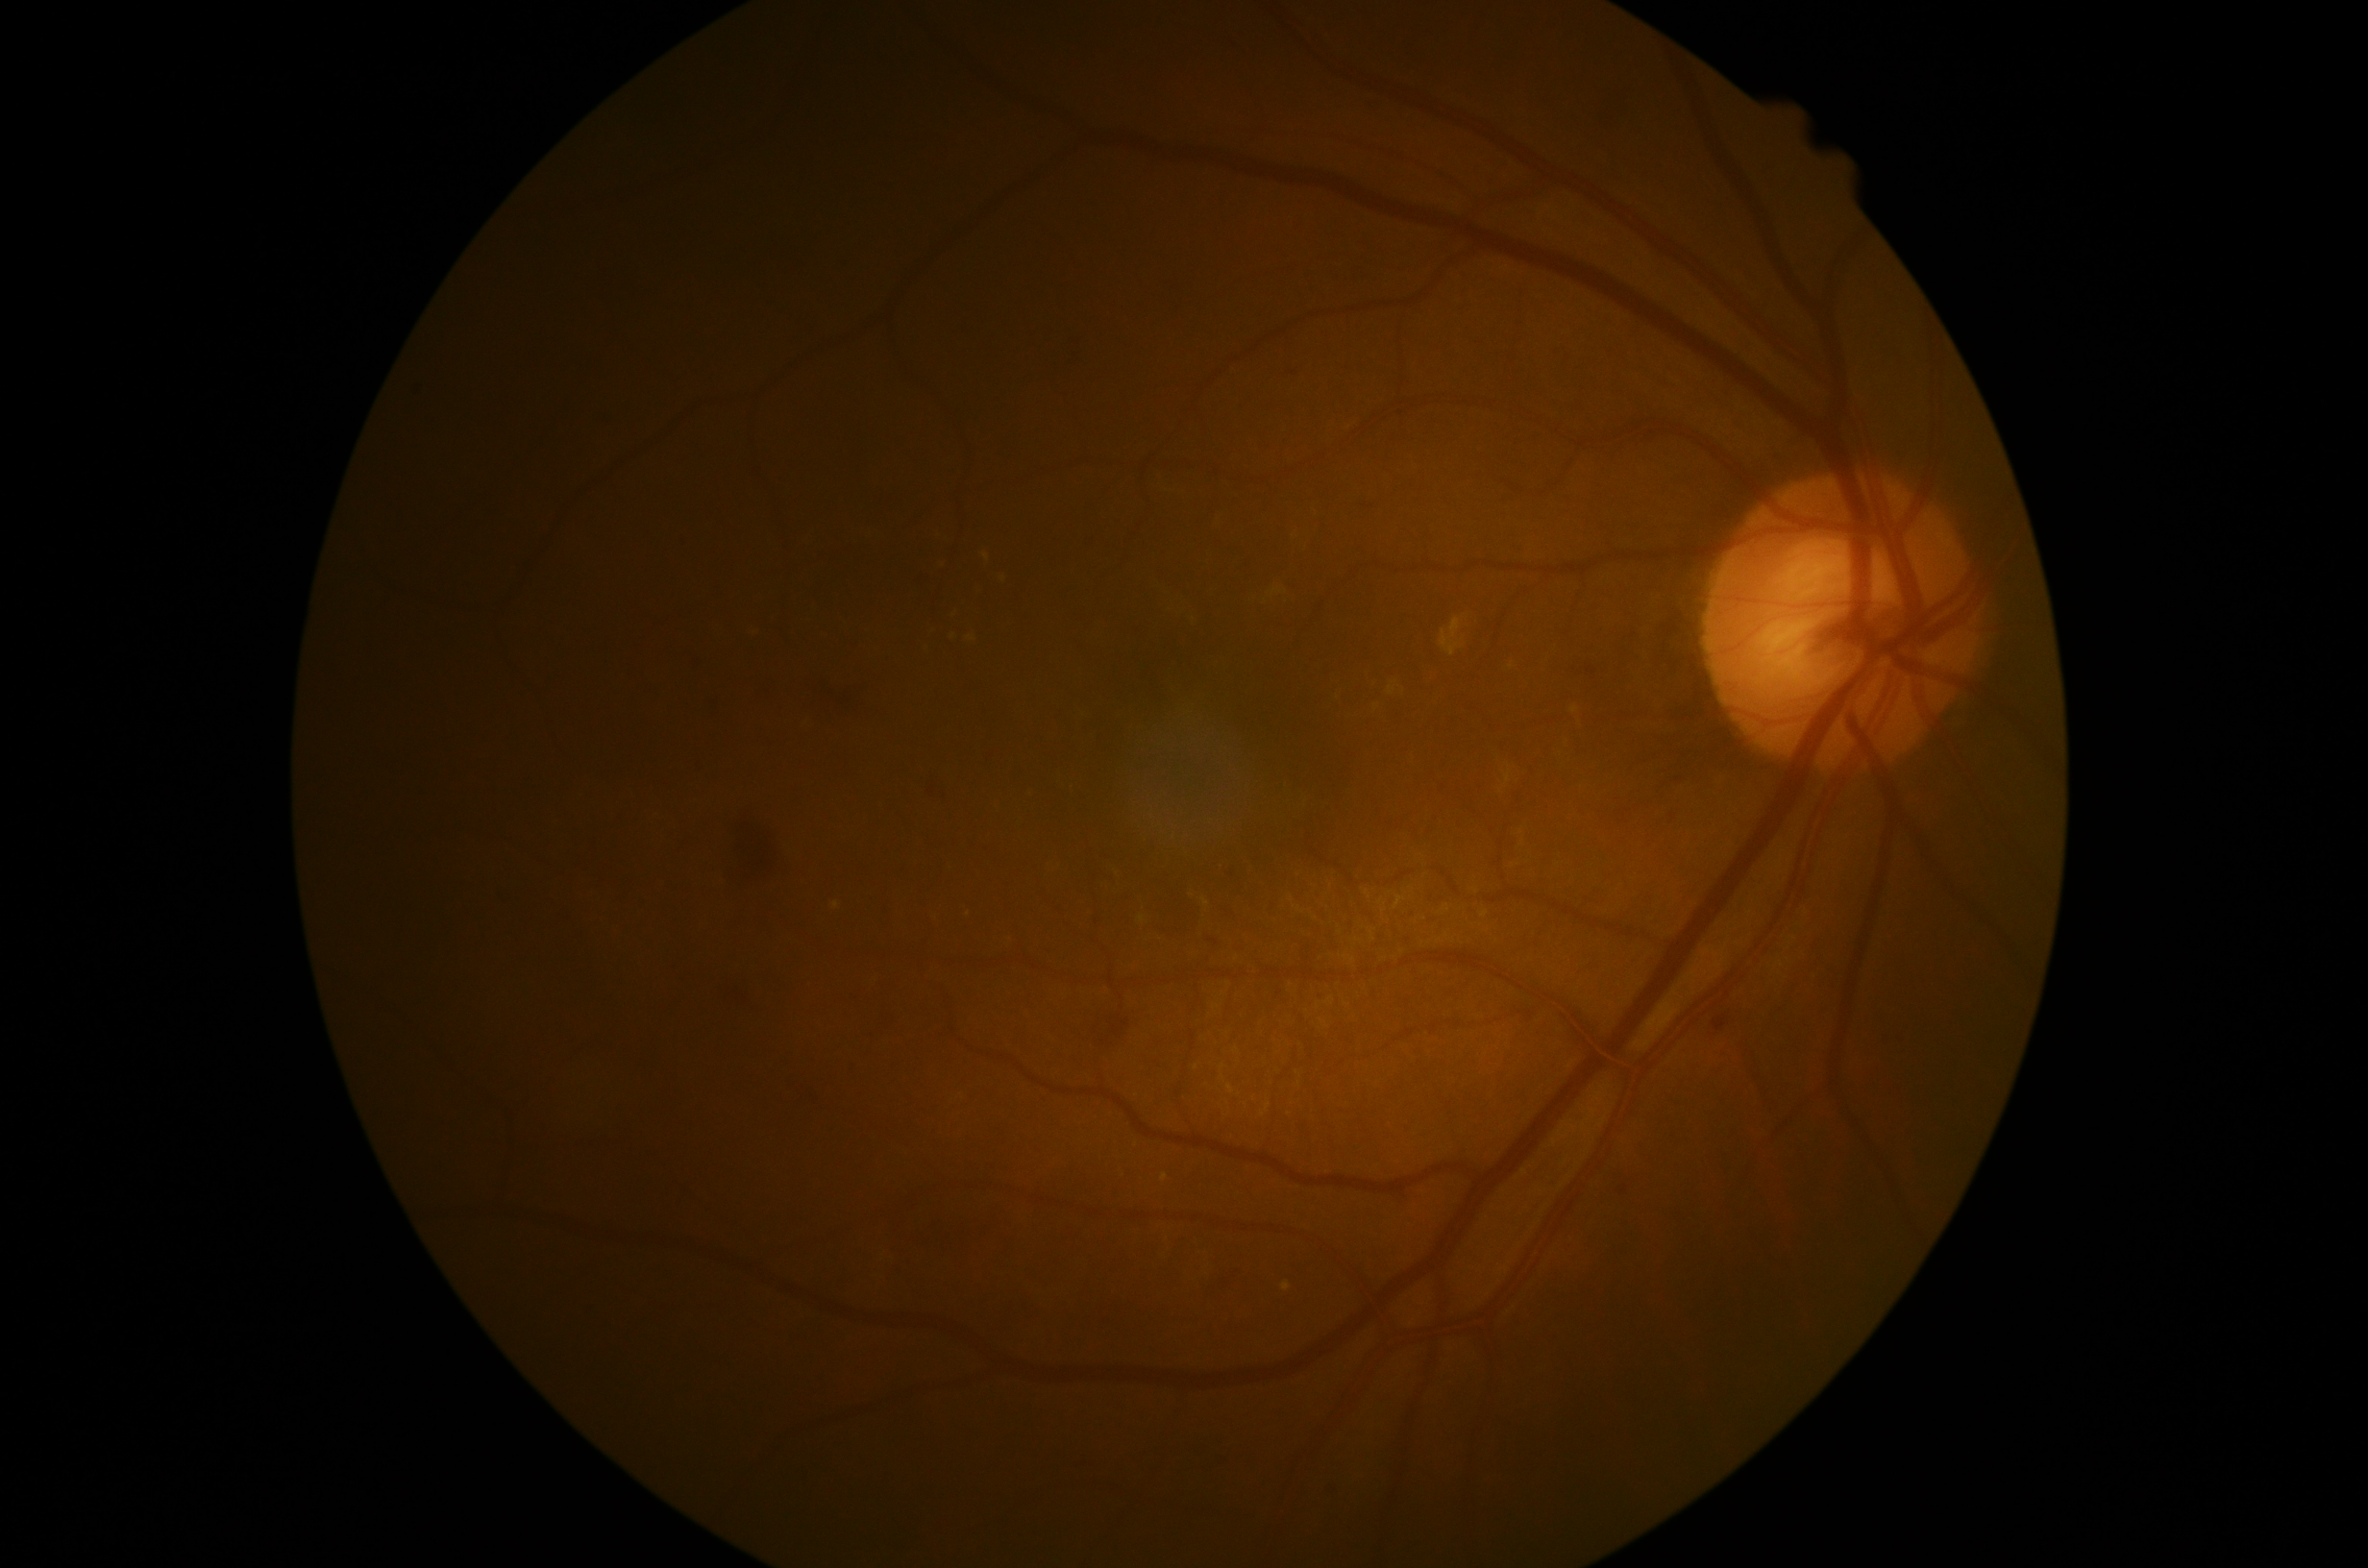

Diabetic retinopathy is grade 2.